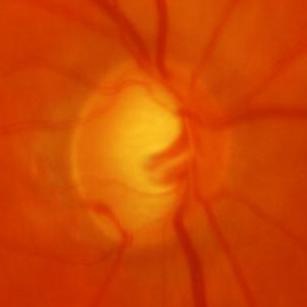 Assessment: glaucoma.